Wide-field fundus photograph of an infant — 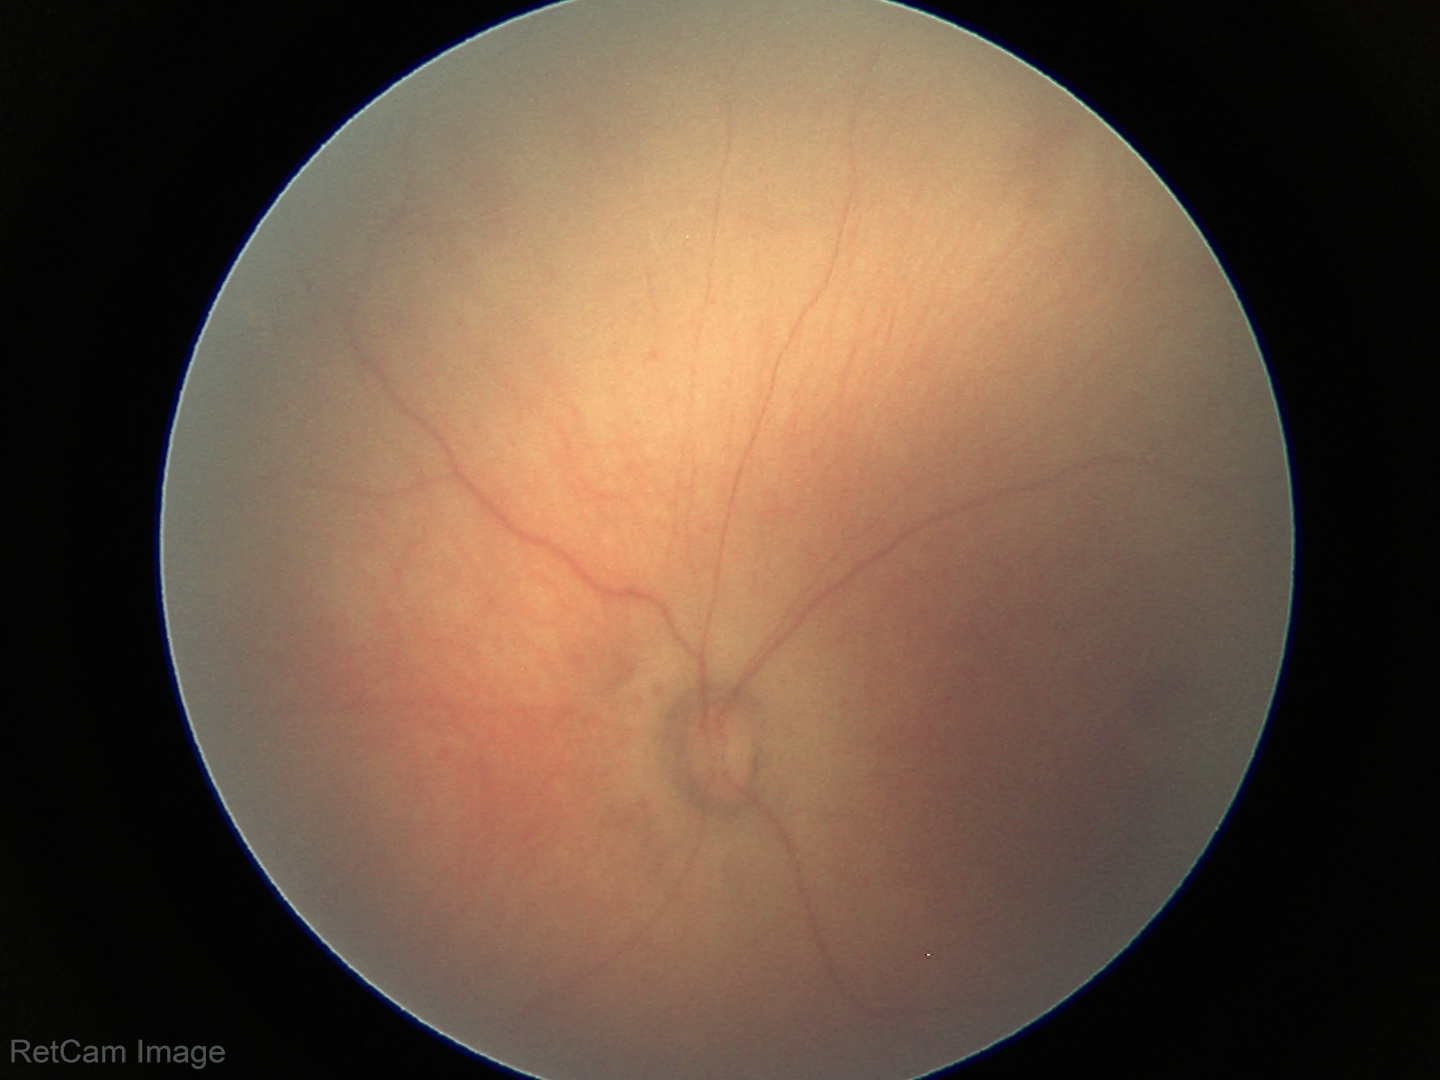 No retinal pathology identified on screening.